1240 by 1240 pixels · Phoenix ICON, 100° FOV · wide-field fundus photograph of an infant: 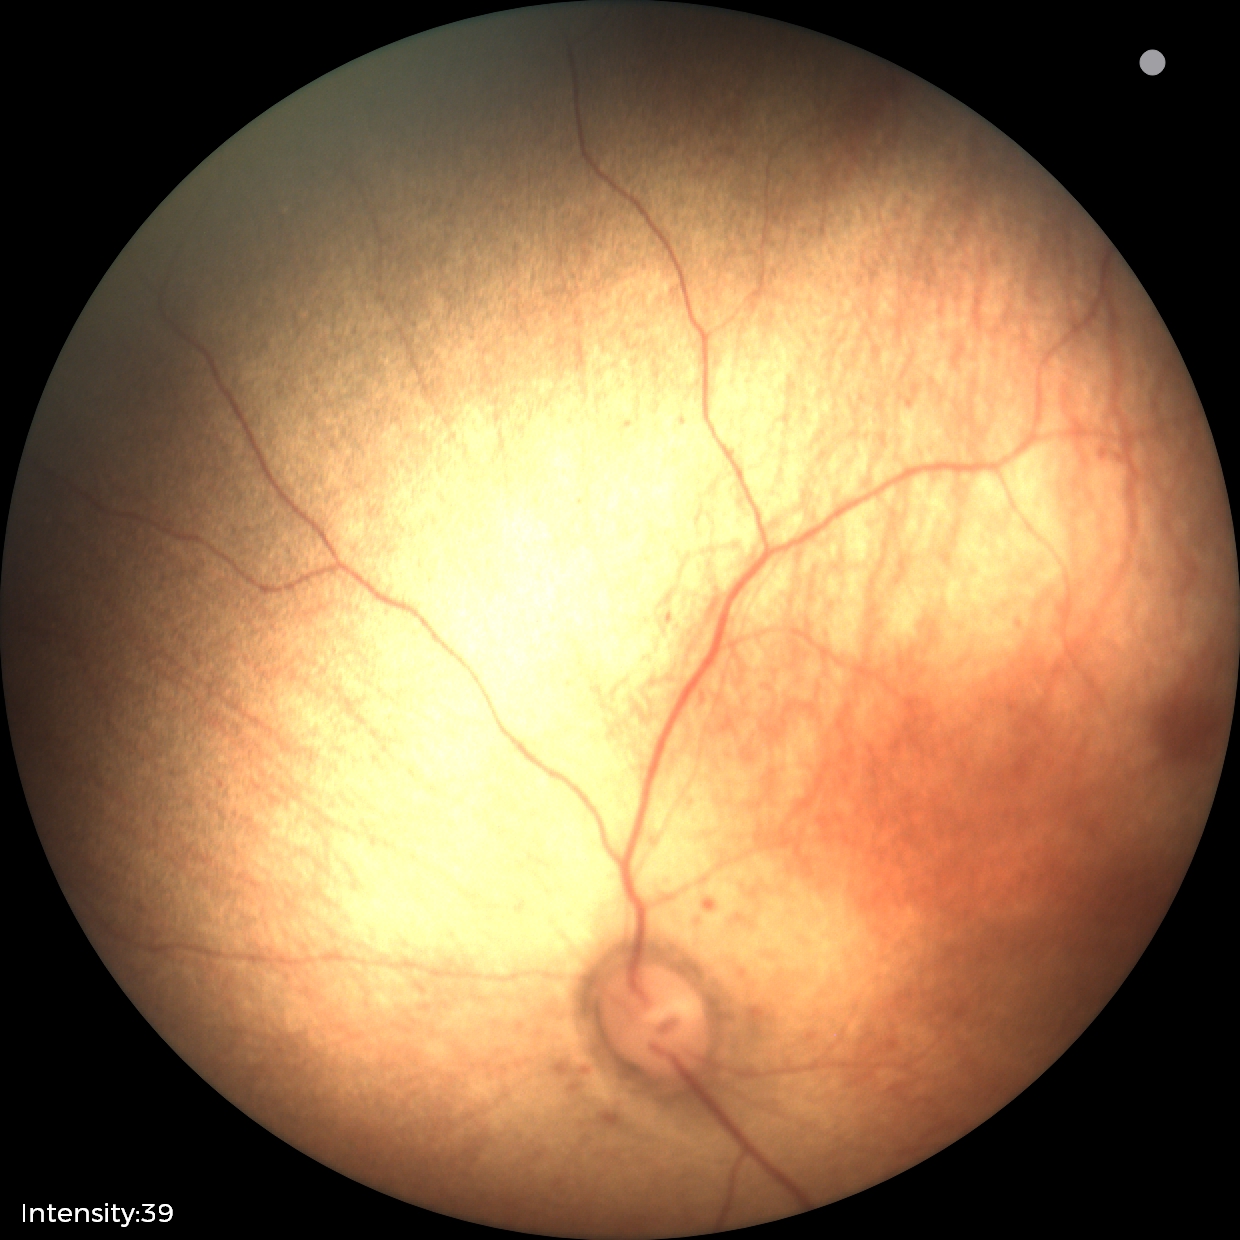

Impression = normal